Modified Davis grading · nonmydriatic · posterior pole color fundus photograph · acquired with a NIDEK AFC-230.
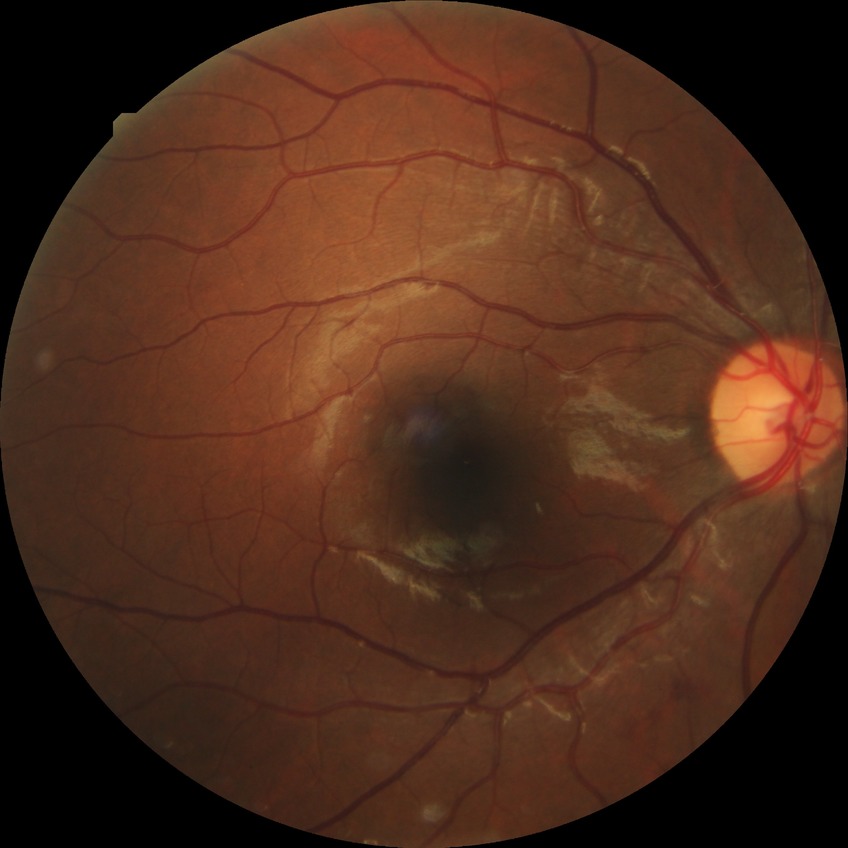
davis_grade: simple diabetic retinopathy